DR severity per modified Davis staging; image size 848x848
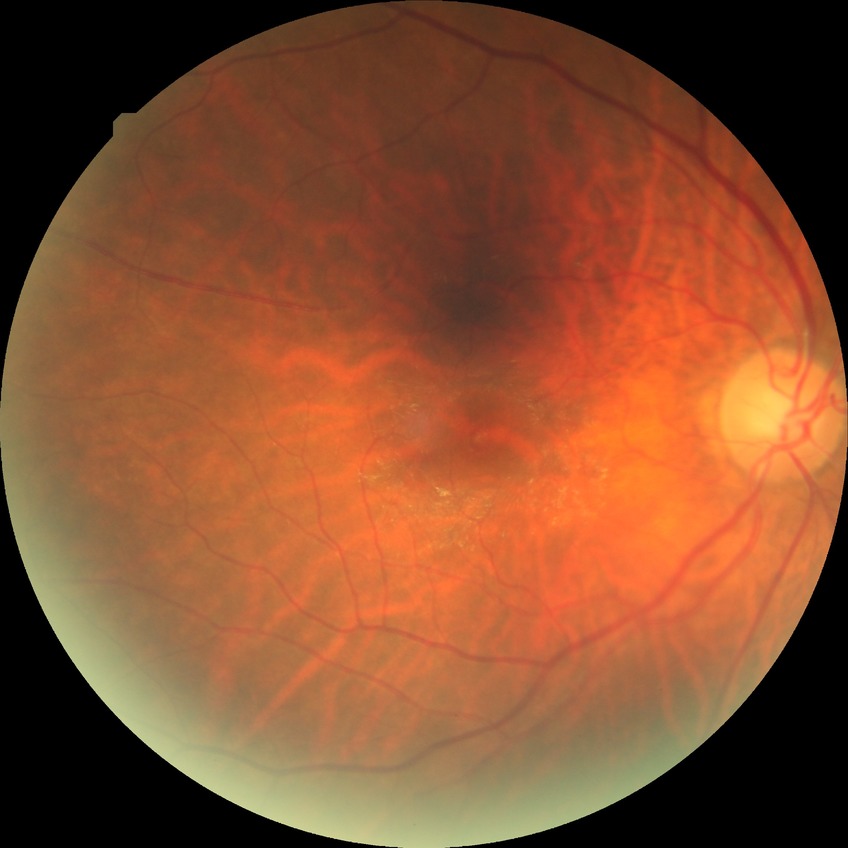 Retinopathy stage is simple diabetic retinopathy.